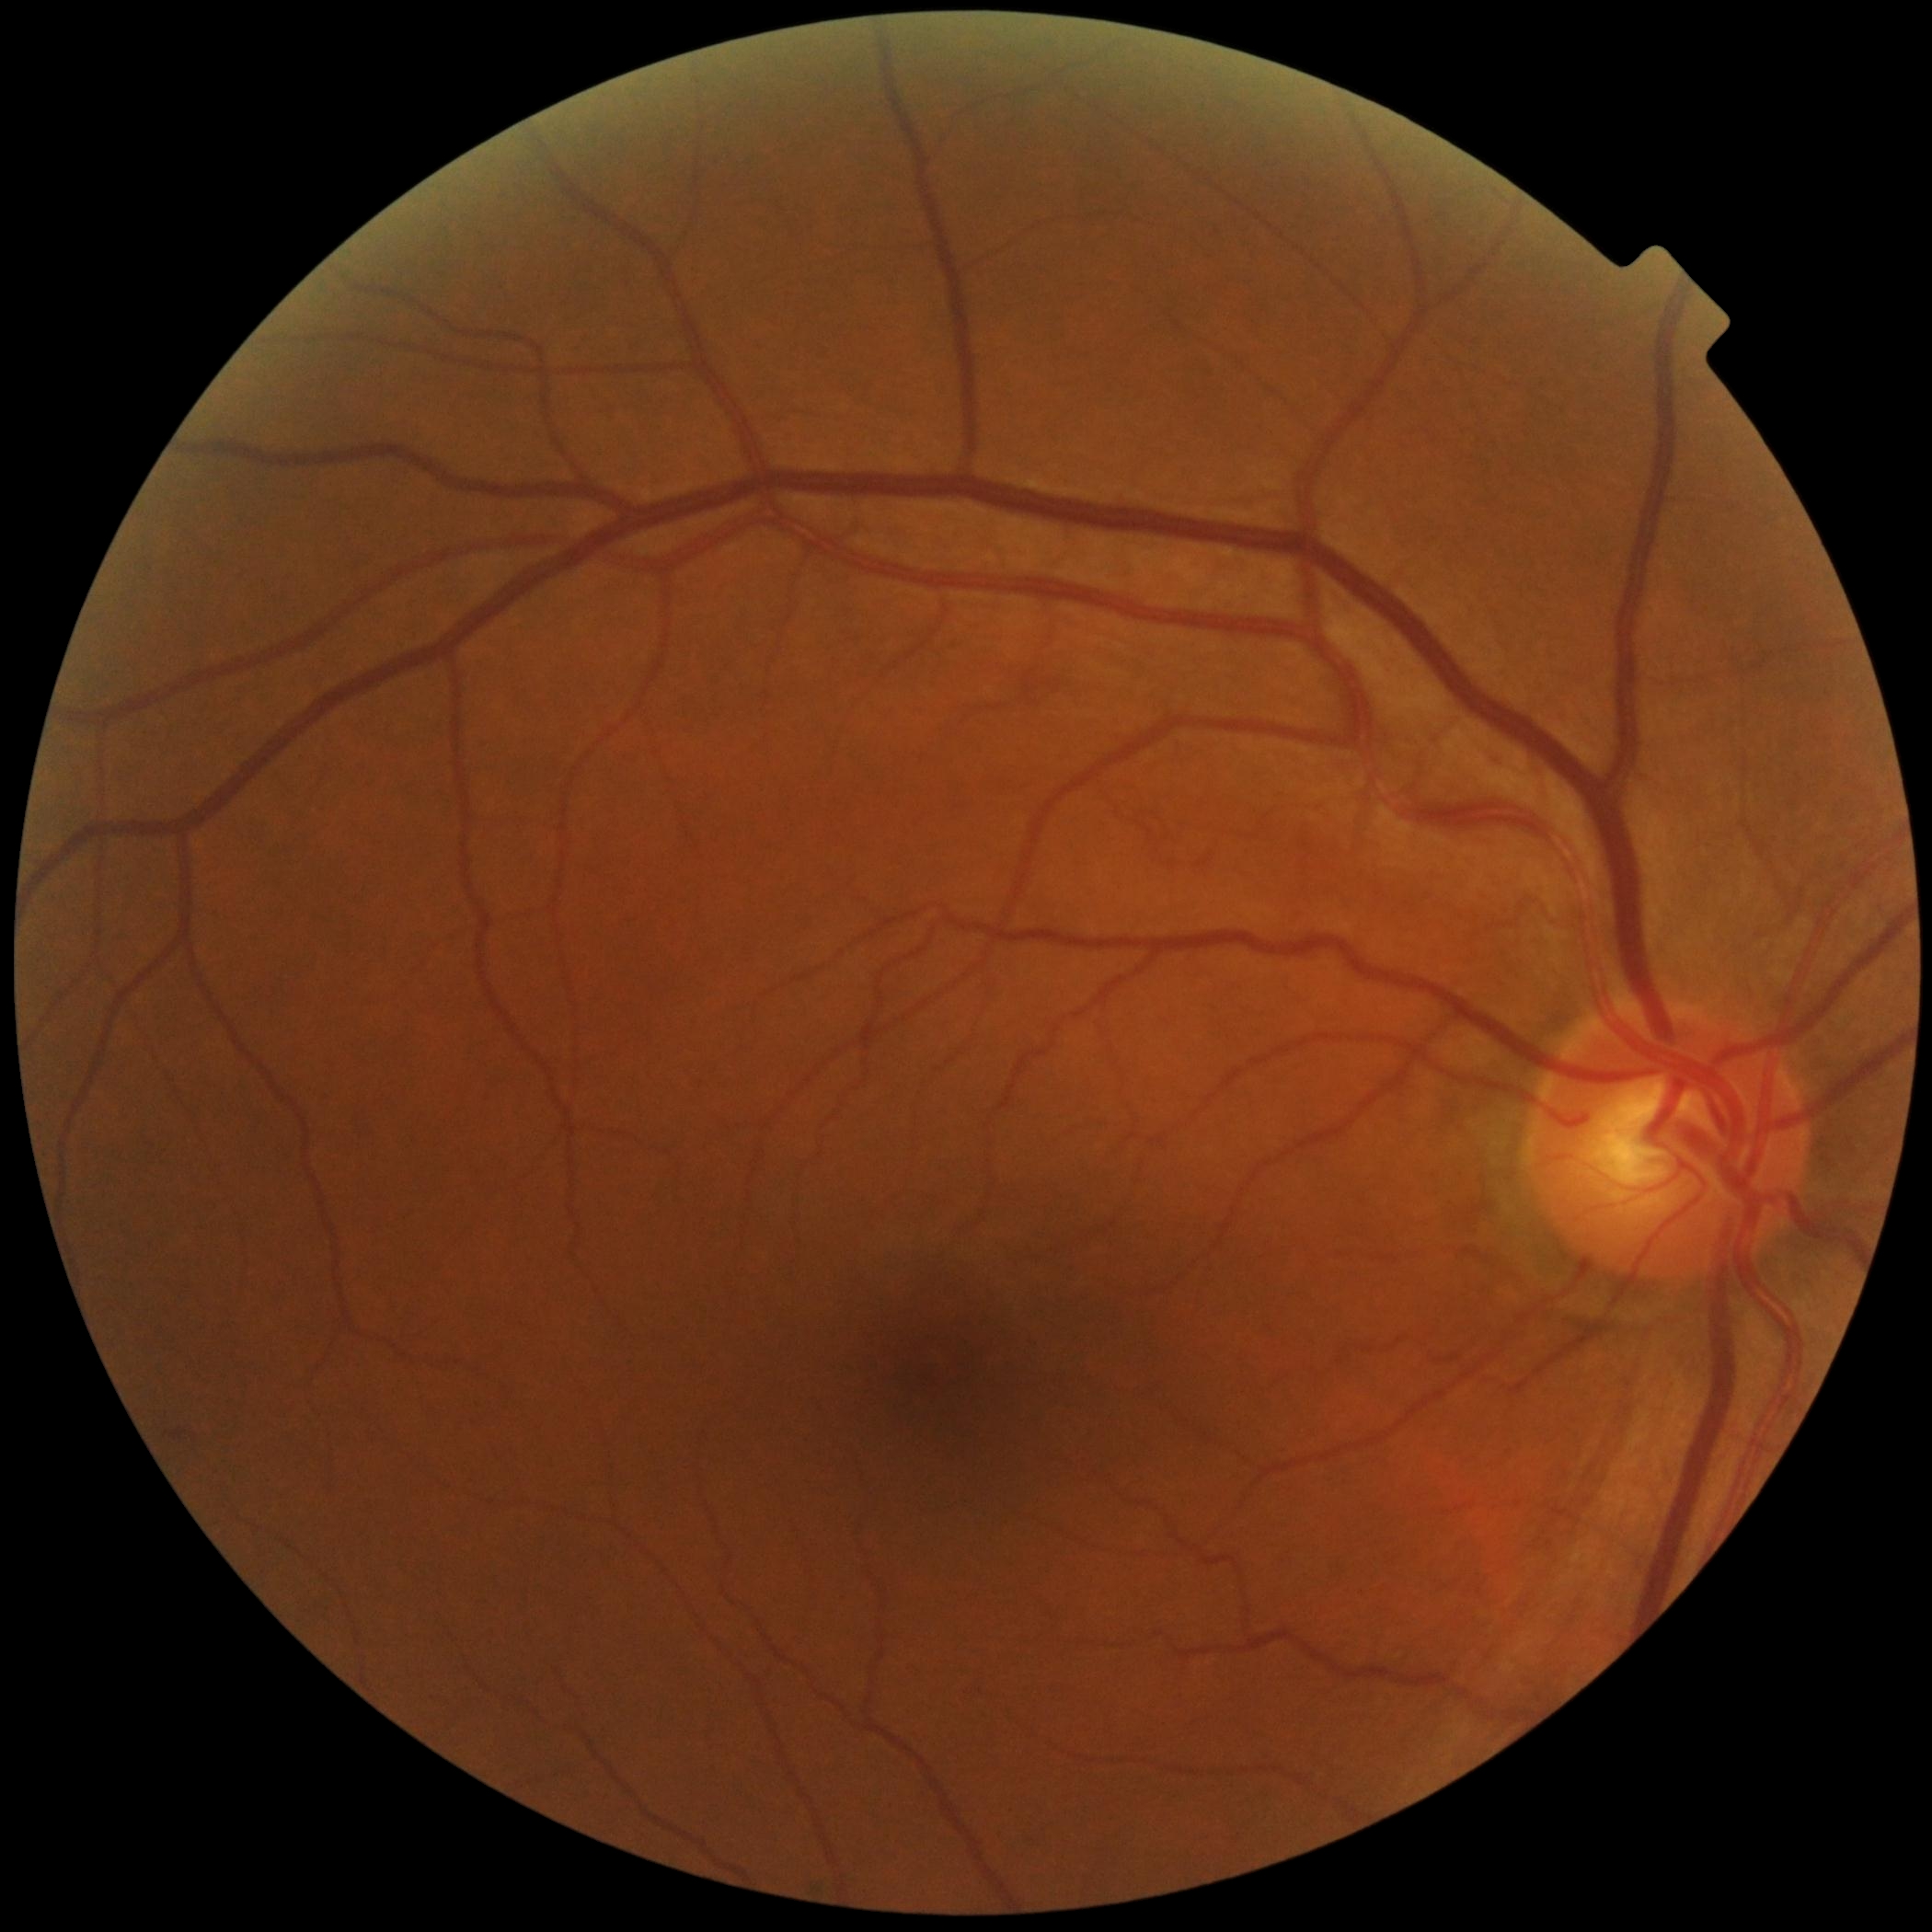

Diabetic retinopathy (DR) is grade 0 (no apparent retinopathy).
No signs of diabetic retinopathy.